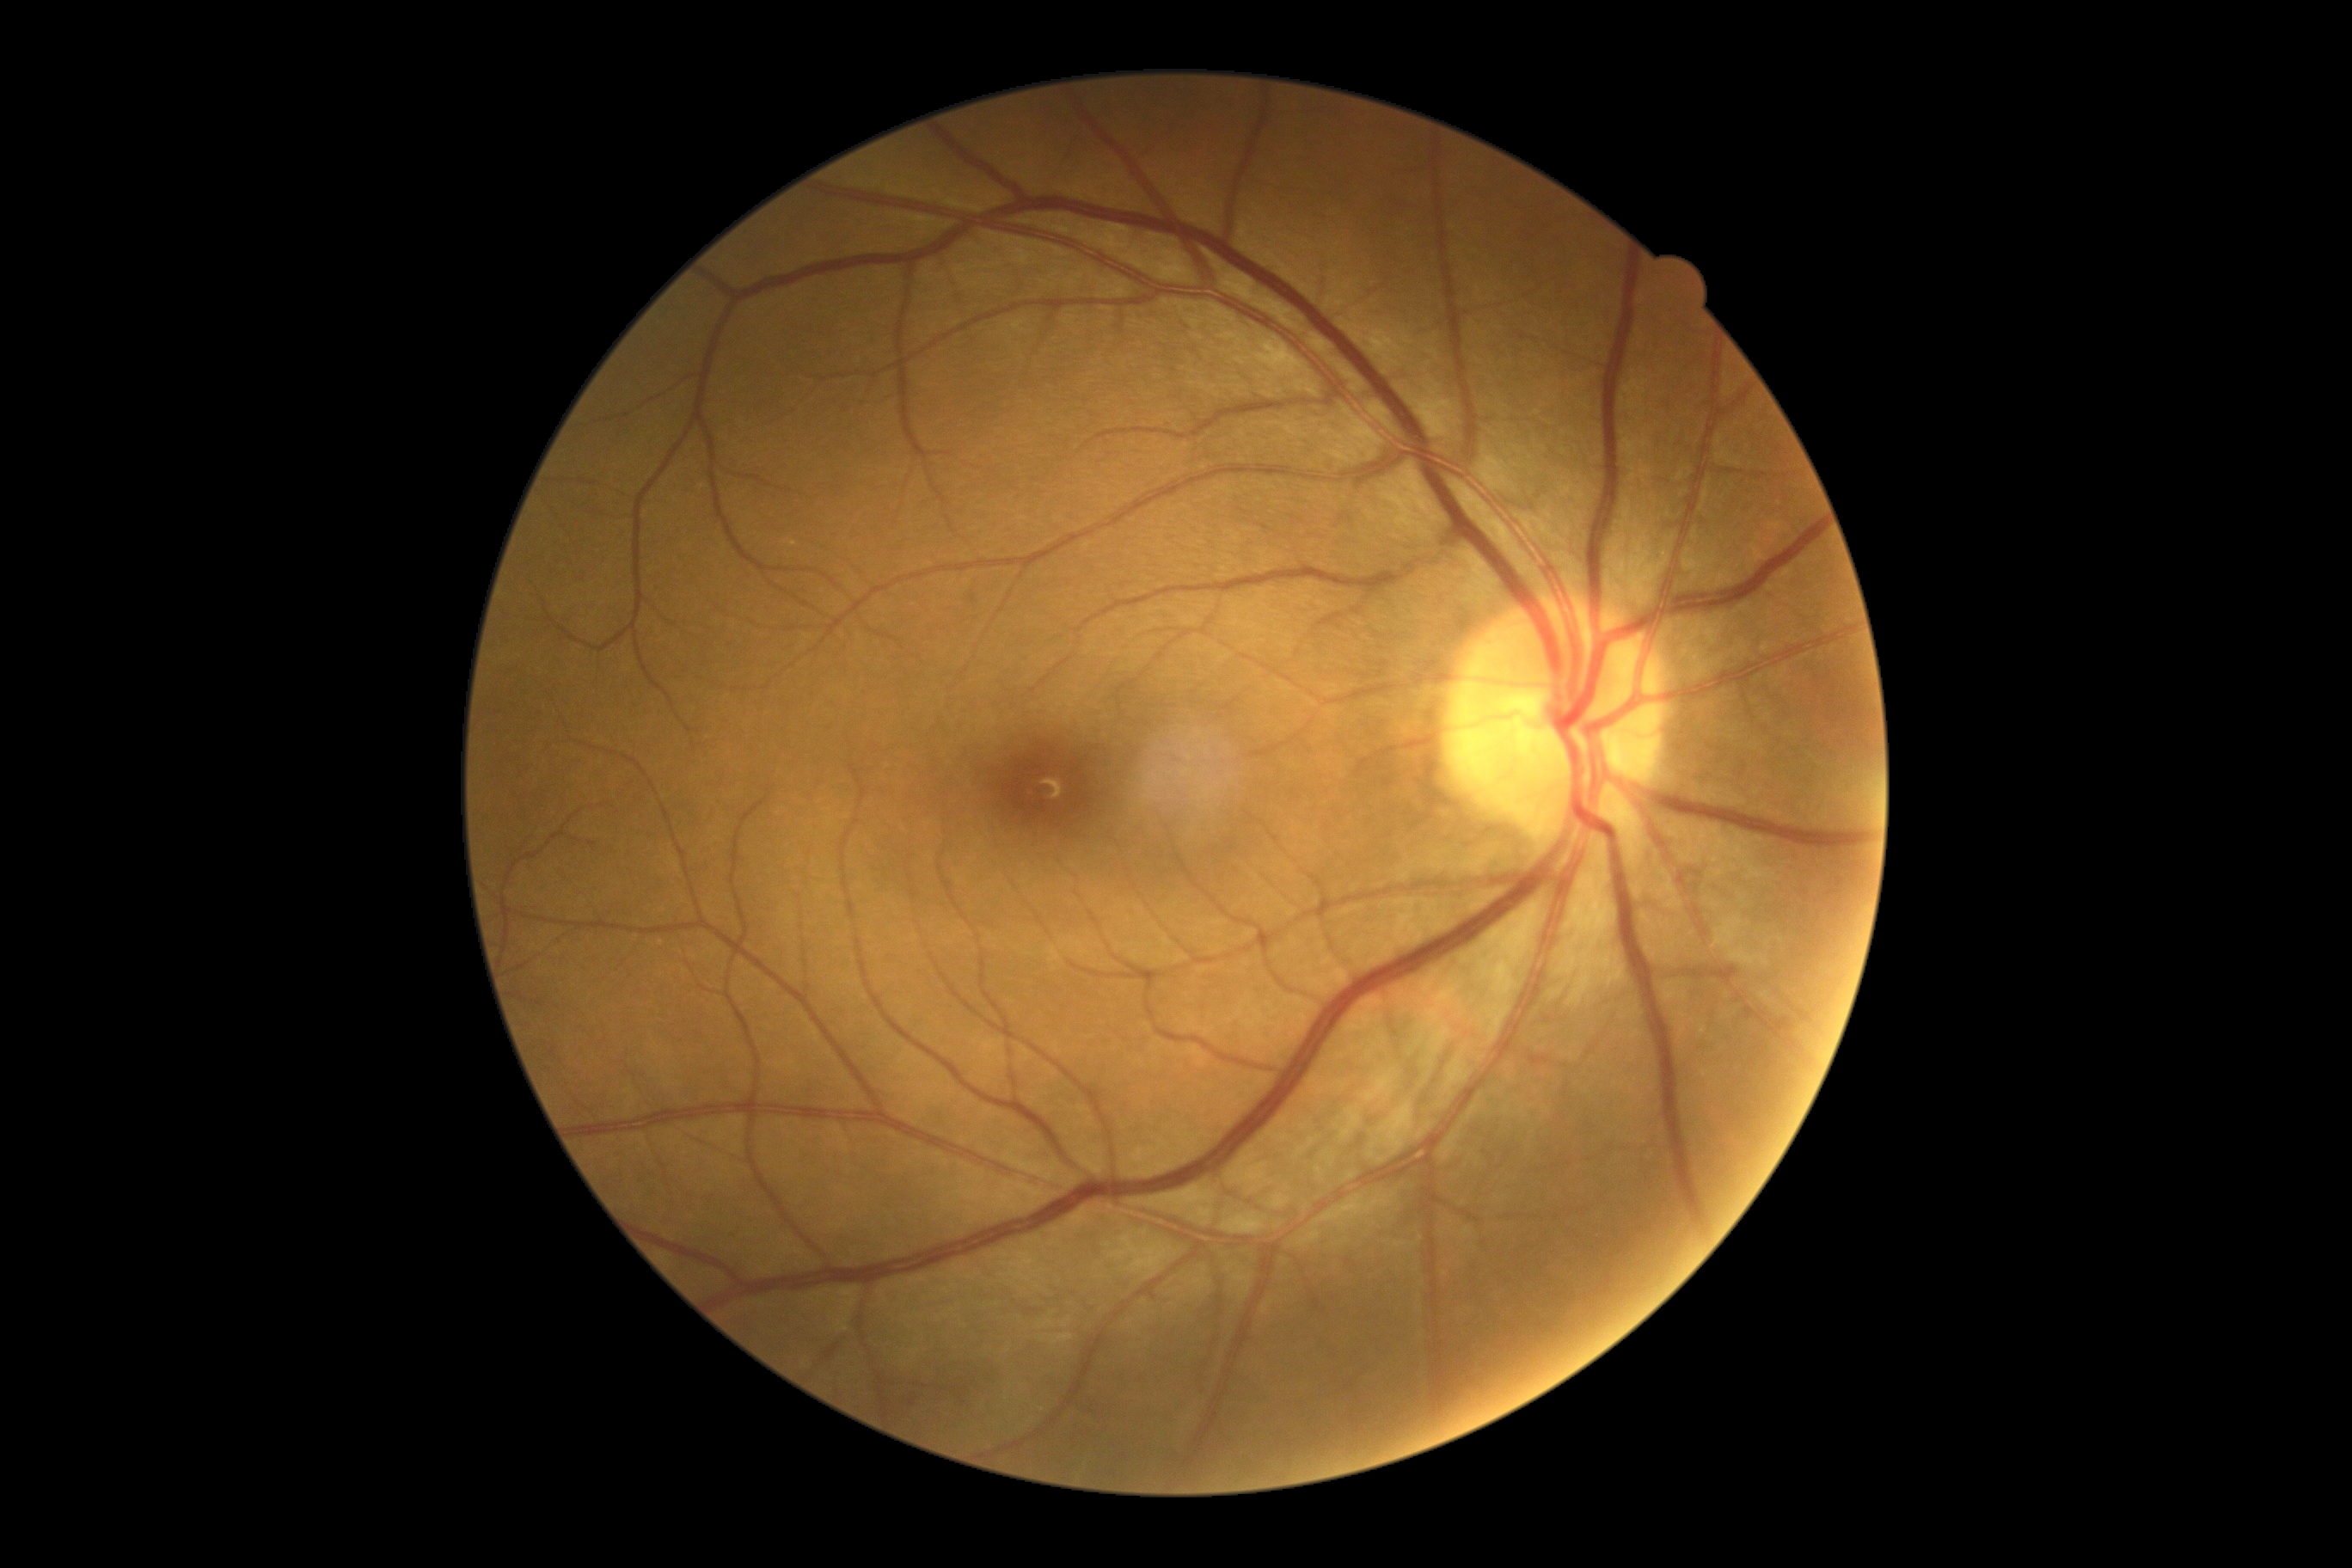

DR impression=no DR findings, diabetic retinopathy (DR)=0.